Nonmydriatic fundus photograph · 45 degree fundus photograph
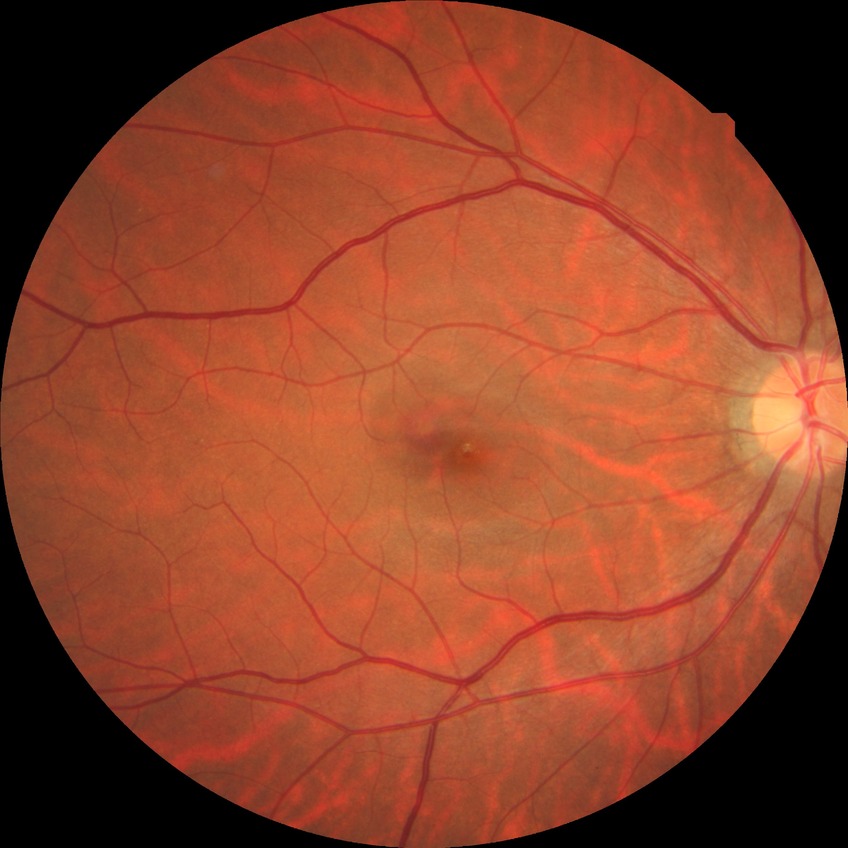 diabetic retinopathy severity = no diabetic retinopathy.